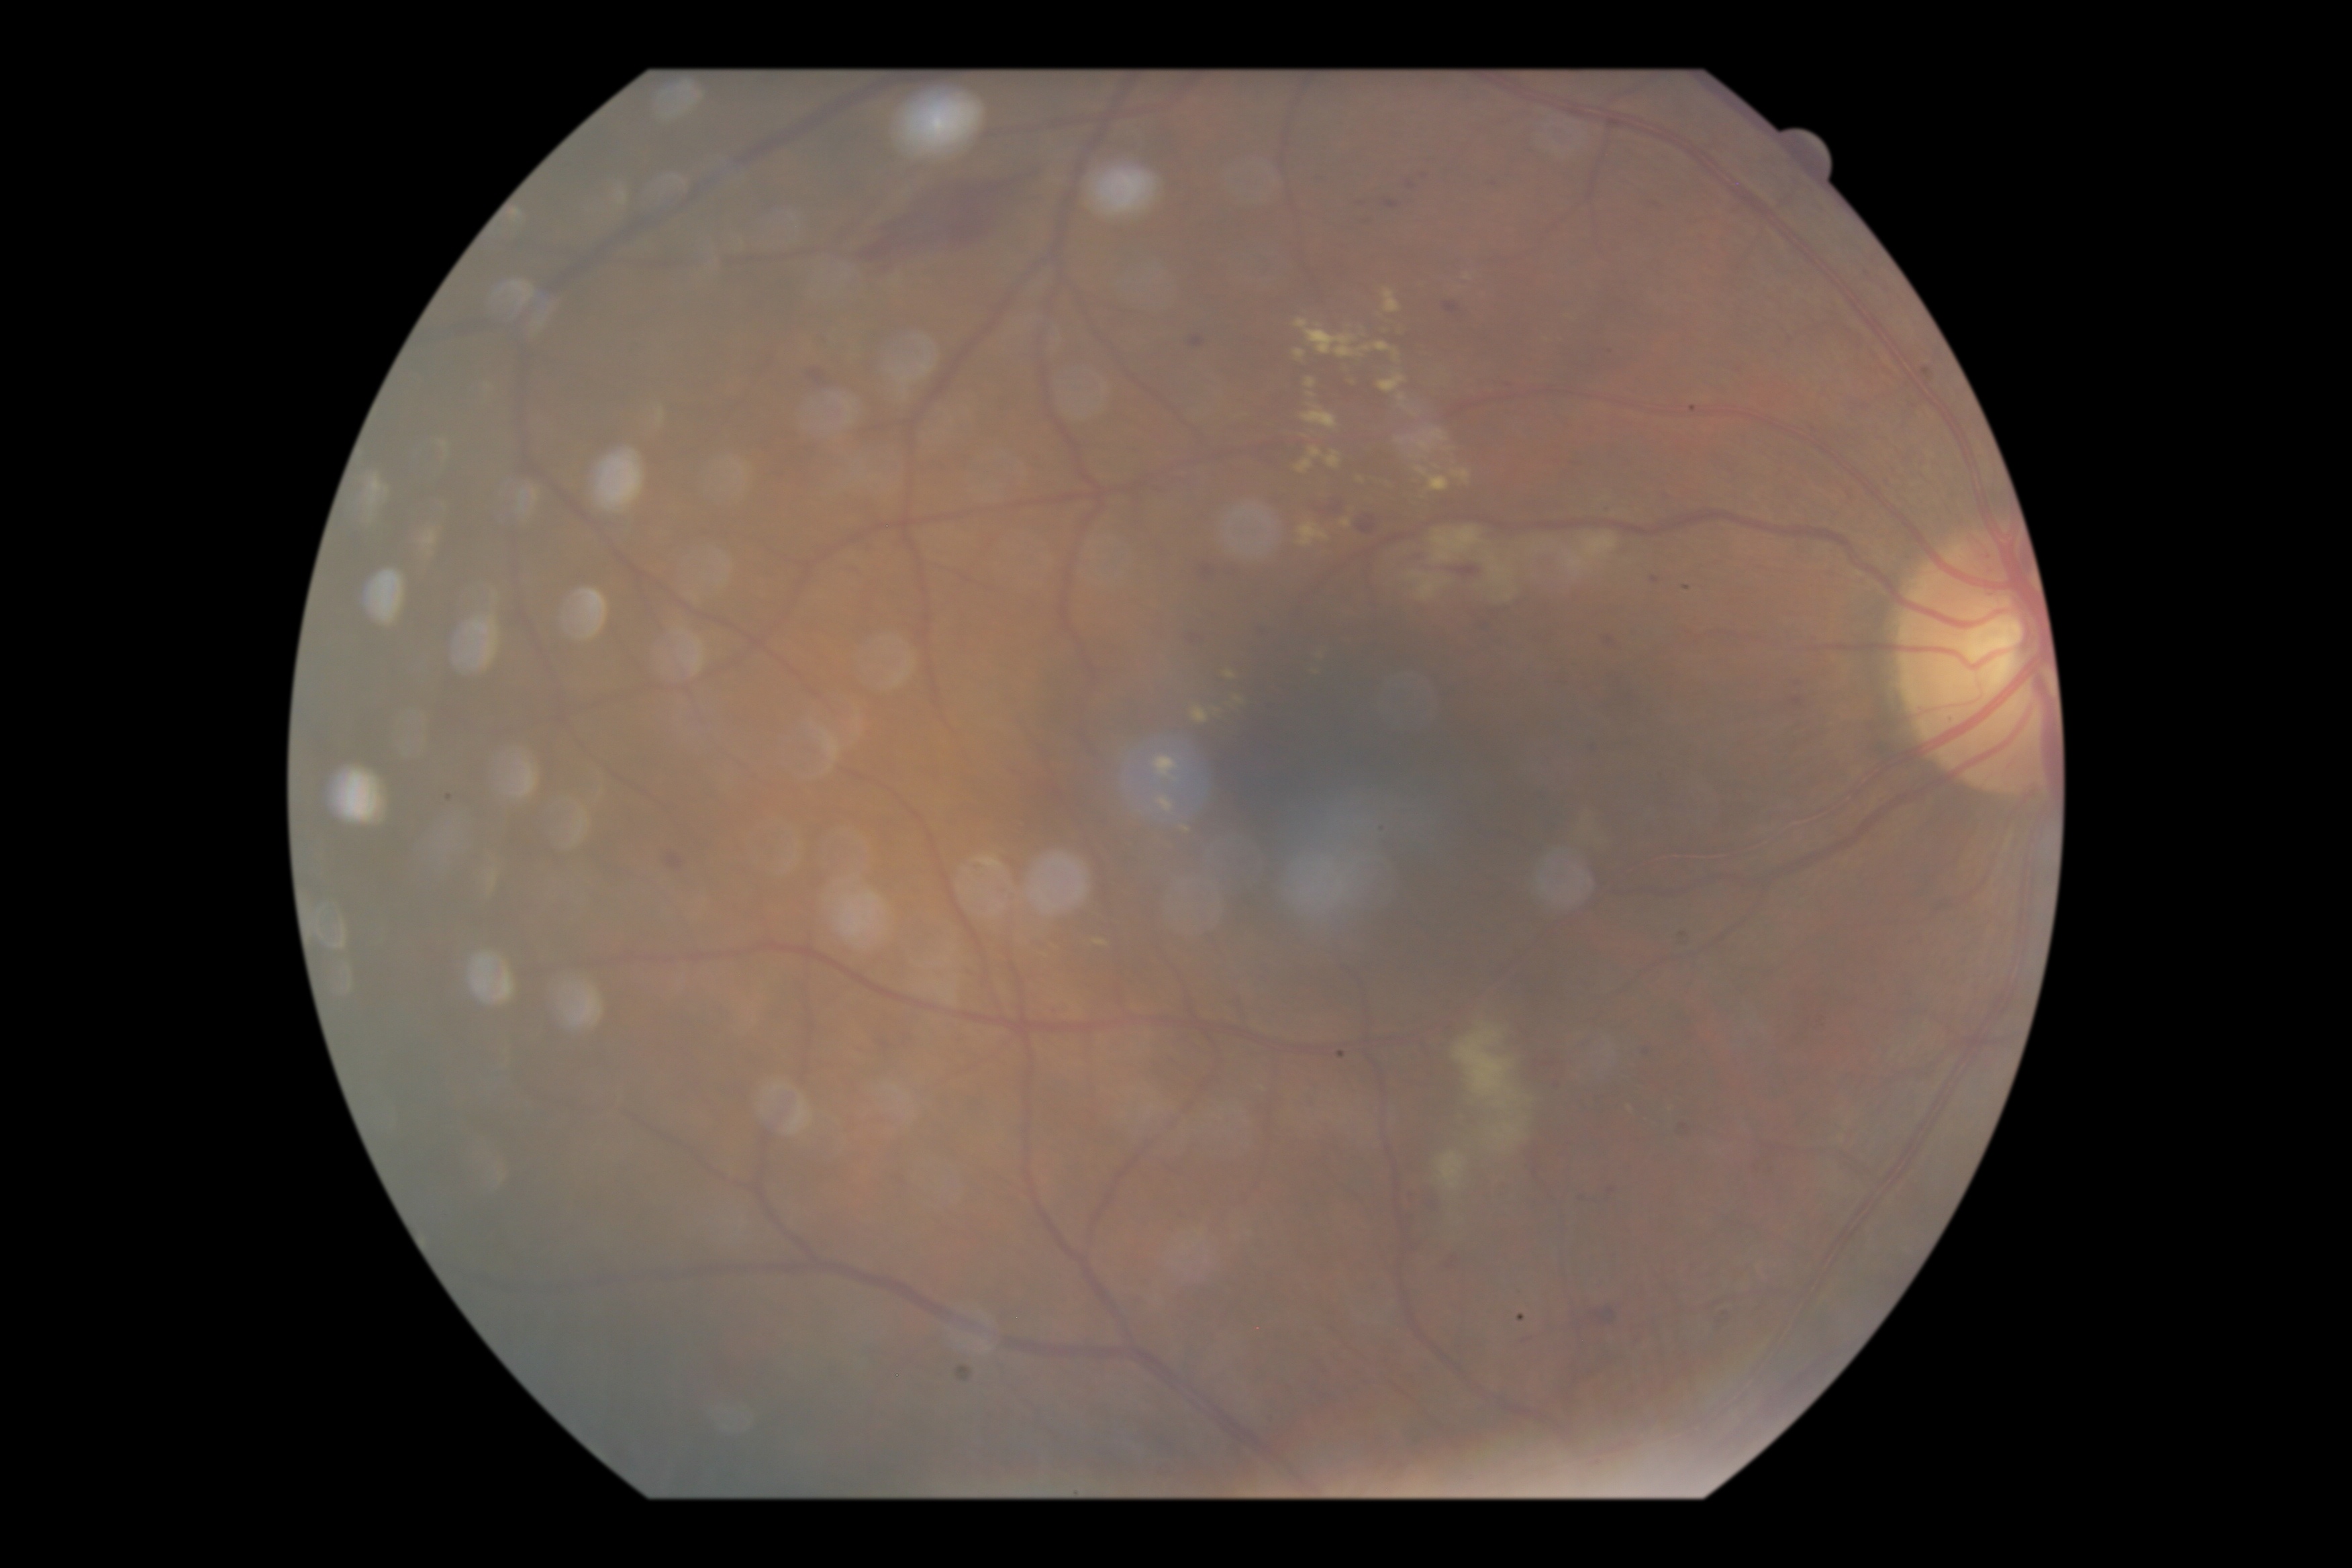
Annotations:
* diabetic retinopathy severity — grade 2 (moderate NPDR)